Davis DR grading · acquired with a NIDEK AFC-230: 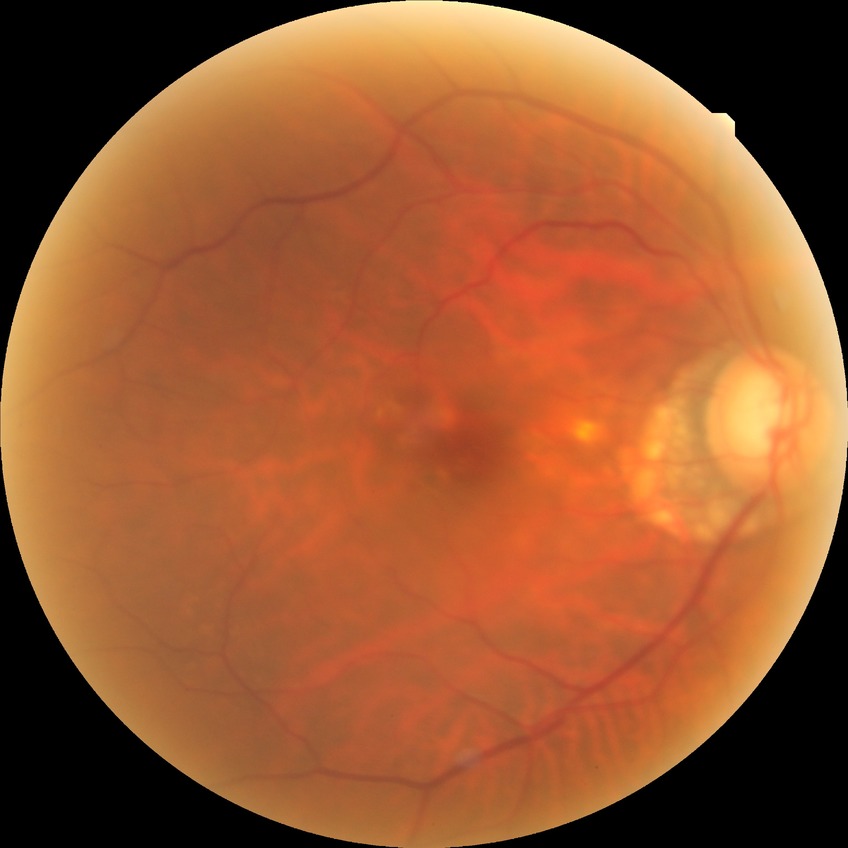 {"davis_grade": "no diabetic retinopathy (NDR)"}